Pediatric wide-field fundus photograph. Image size 640x480: 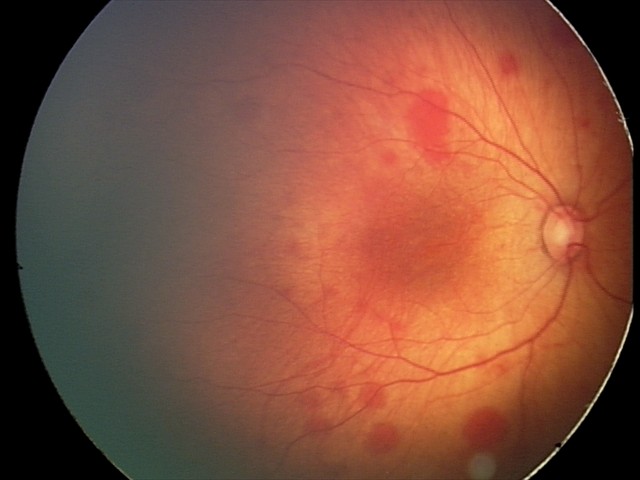 From an examination with diagnosis of retinal hemorrhages.